45° field of view: 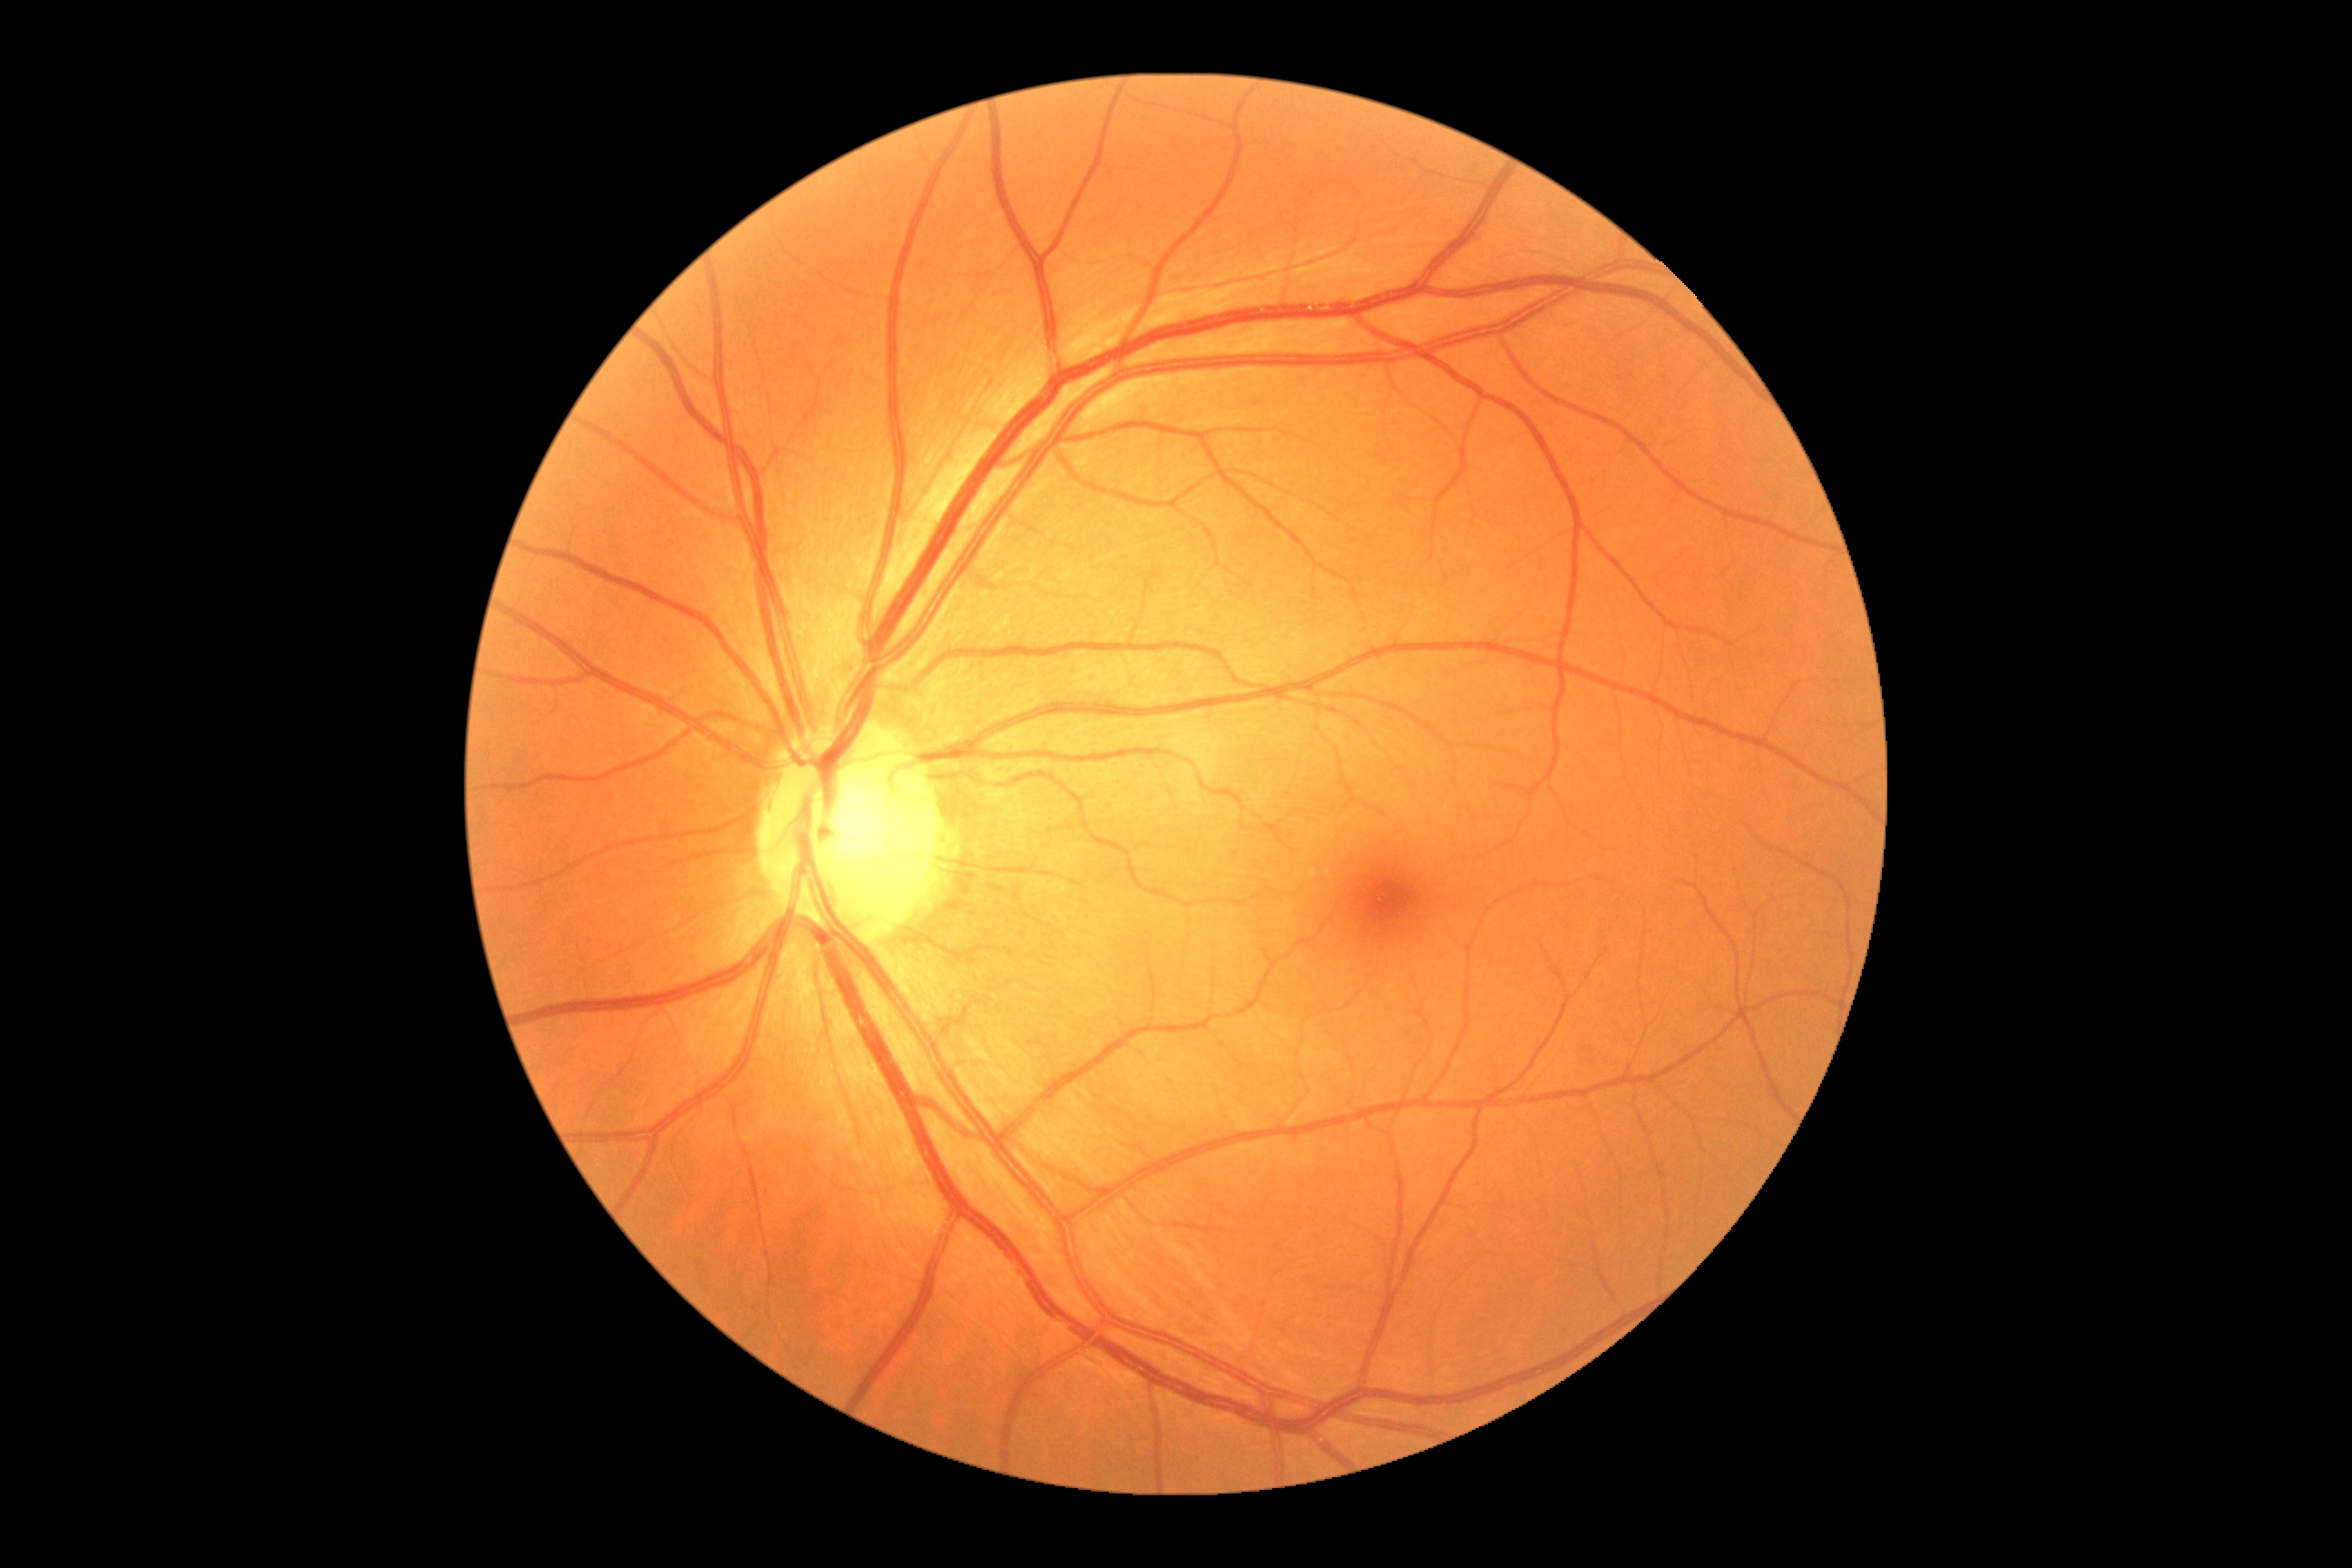 DR impression = no DR findings
DR = no apparent retinopathy (grade 0) — no visible signs of diabetic retinopathy